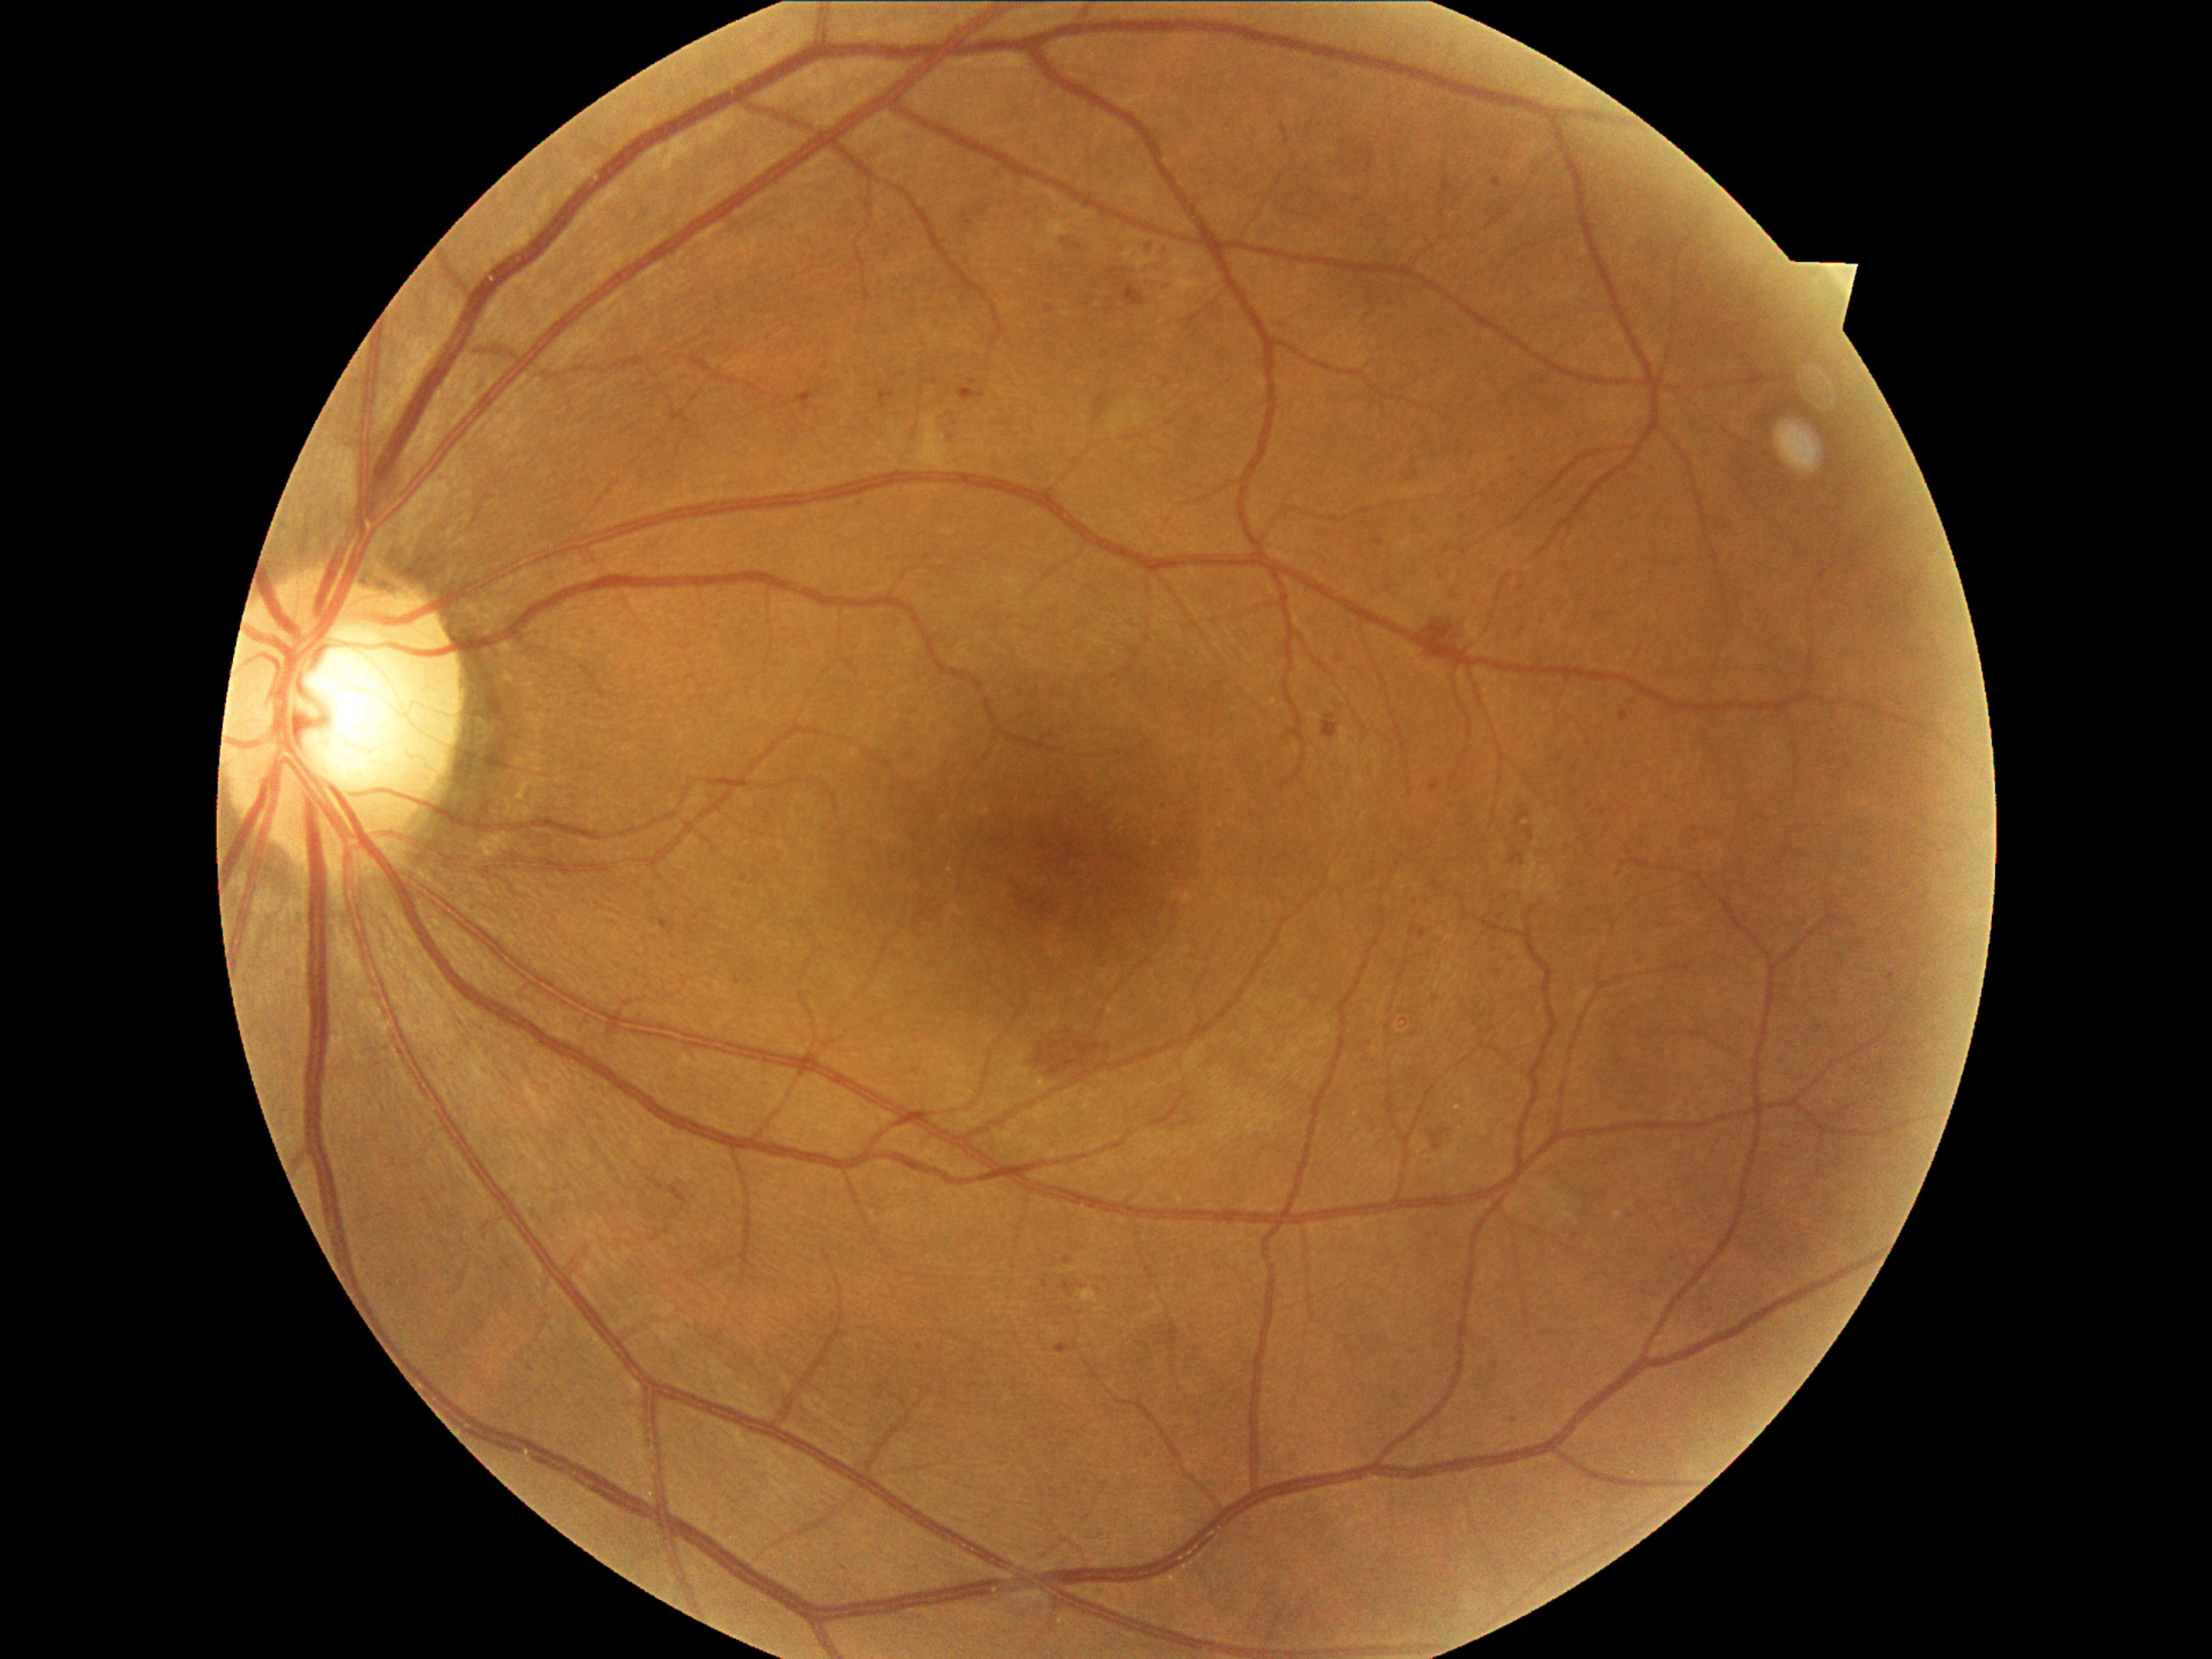
Diabetic retinopathy grade is 2
A subset of detected lesions:
• soft exudates: <box>917,417,957,472</box>, <box>1109,399,1148,436</box>, <box>1124,248,1136,262</box>, <box>1037,221,1071,253</box>, <box>1132,252,1160,271</box>
• hemorrhages: <box>1324,714,1337,738</box>, <box>1527,827,1535,842</box>, <box>1433,1134,1443,1150</box>, <box>1027,1028,1114,1080</box>, <box>668,1187,690,1206</box>, <box>1515,805,1527,825</box>, <box>649,1177,665,1190</box>, <box>1421,612,1464,660</box>, <box>1511,853,1523,866</box>
• microaneurysms (more not shown): <box>963,387,974,399</box>, <box>1160,248,1167,257</box>, <box>1375,537,1385,547</box>, <box>1124,286,1146,308</box>, <box>1141,240,1153,245</box>, <box>805,387,812,402</box>, <box>1168,279,1177,284</box>, <box>883,387,895,399</box>, <box>1283,125,1288,136</box>, <box>1621,711,1629,721</box>
• Additional small microaneurysms near [1513, 1420], [1618, 876], [971, 223], [1165, 807], [1404, 1028], [1434, 787]
• hard exudates: <box>1083,1289,1098,1305</box>, <box>1033,1080,1054,1093</box>, <box>1614,1211,1624,1220</box>
• Additional small hard exudates near [1458, 1109], [1397, 1029], [1525, 822]